DR severity per modified Davis staging
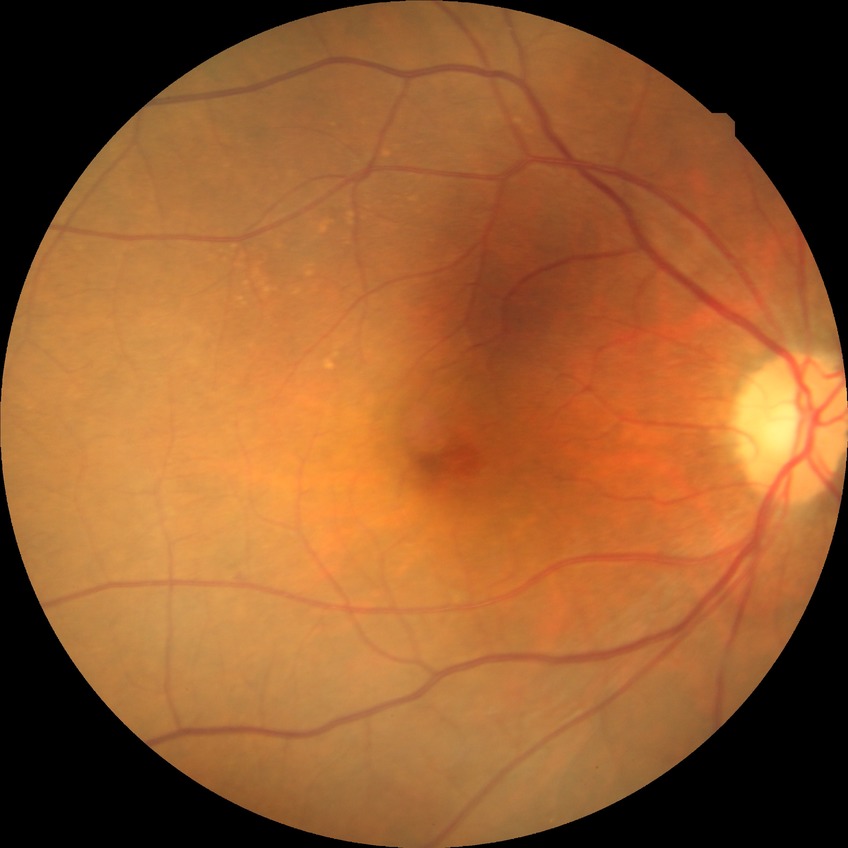
Diabetic retinopathy (DR): NDR (no diabetic retinopathy).